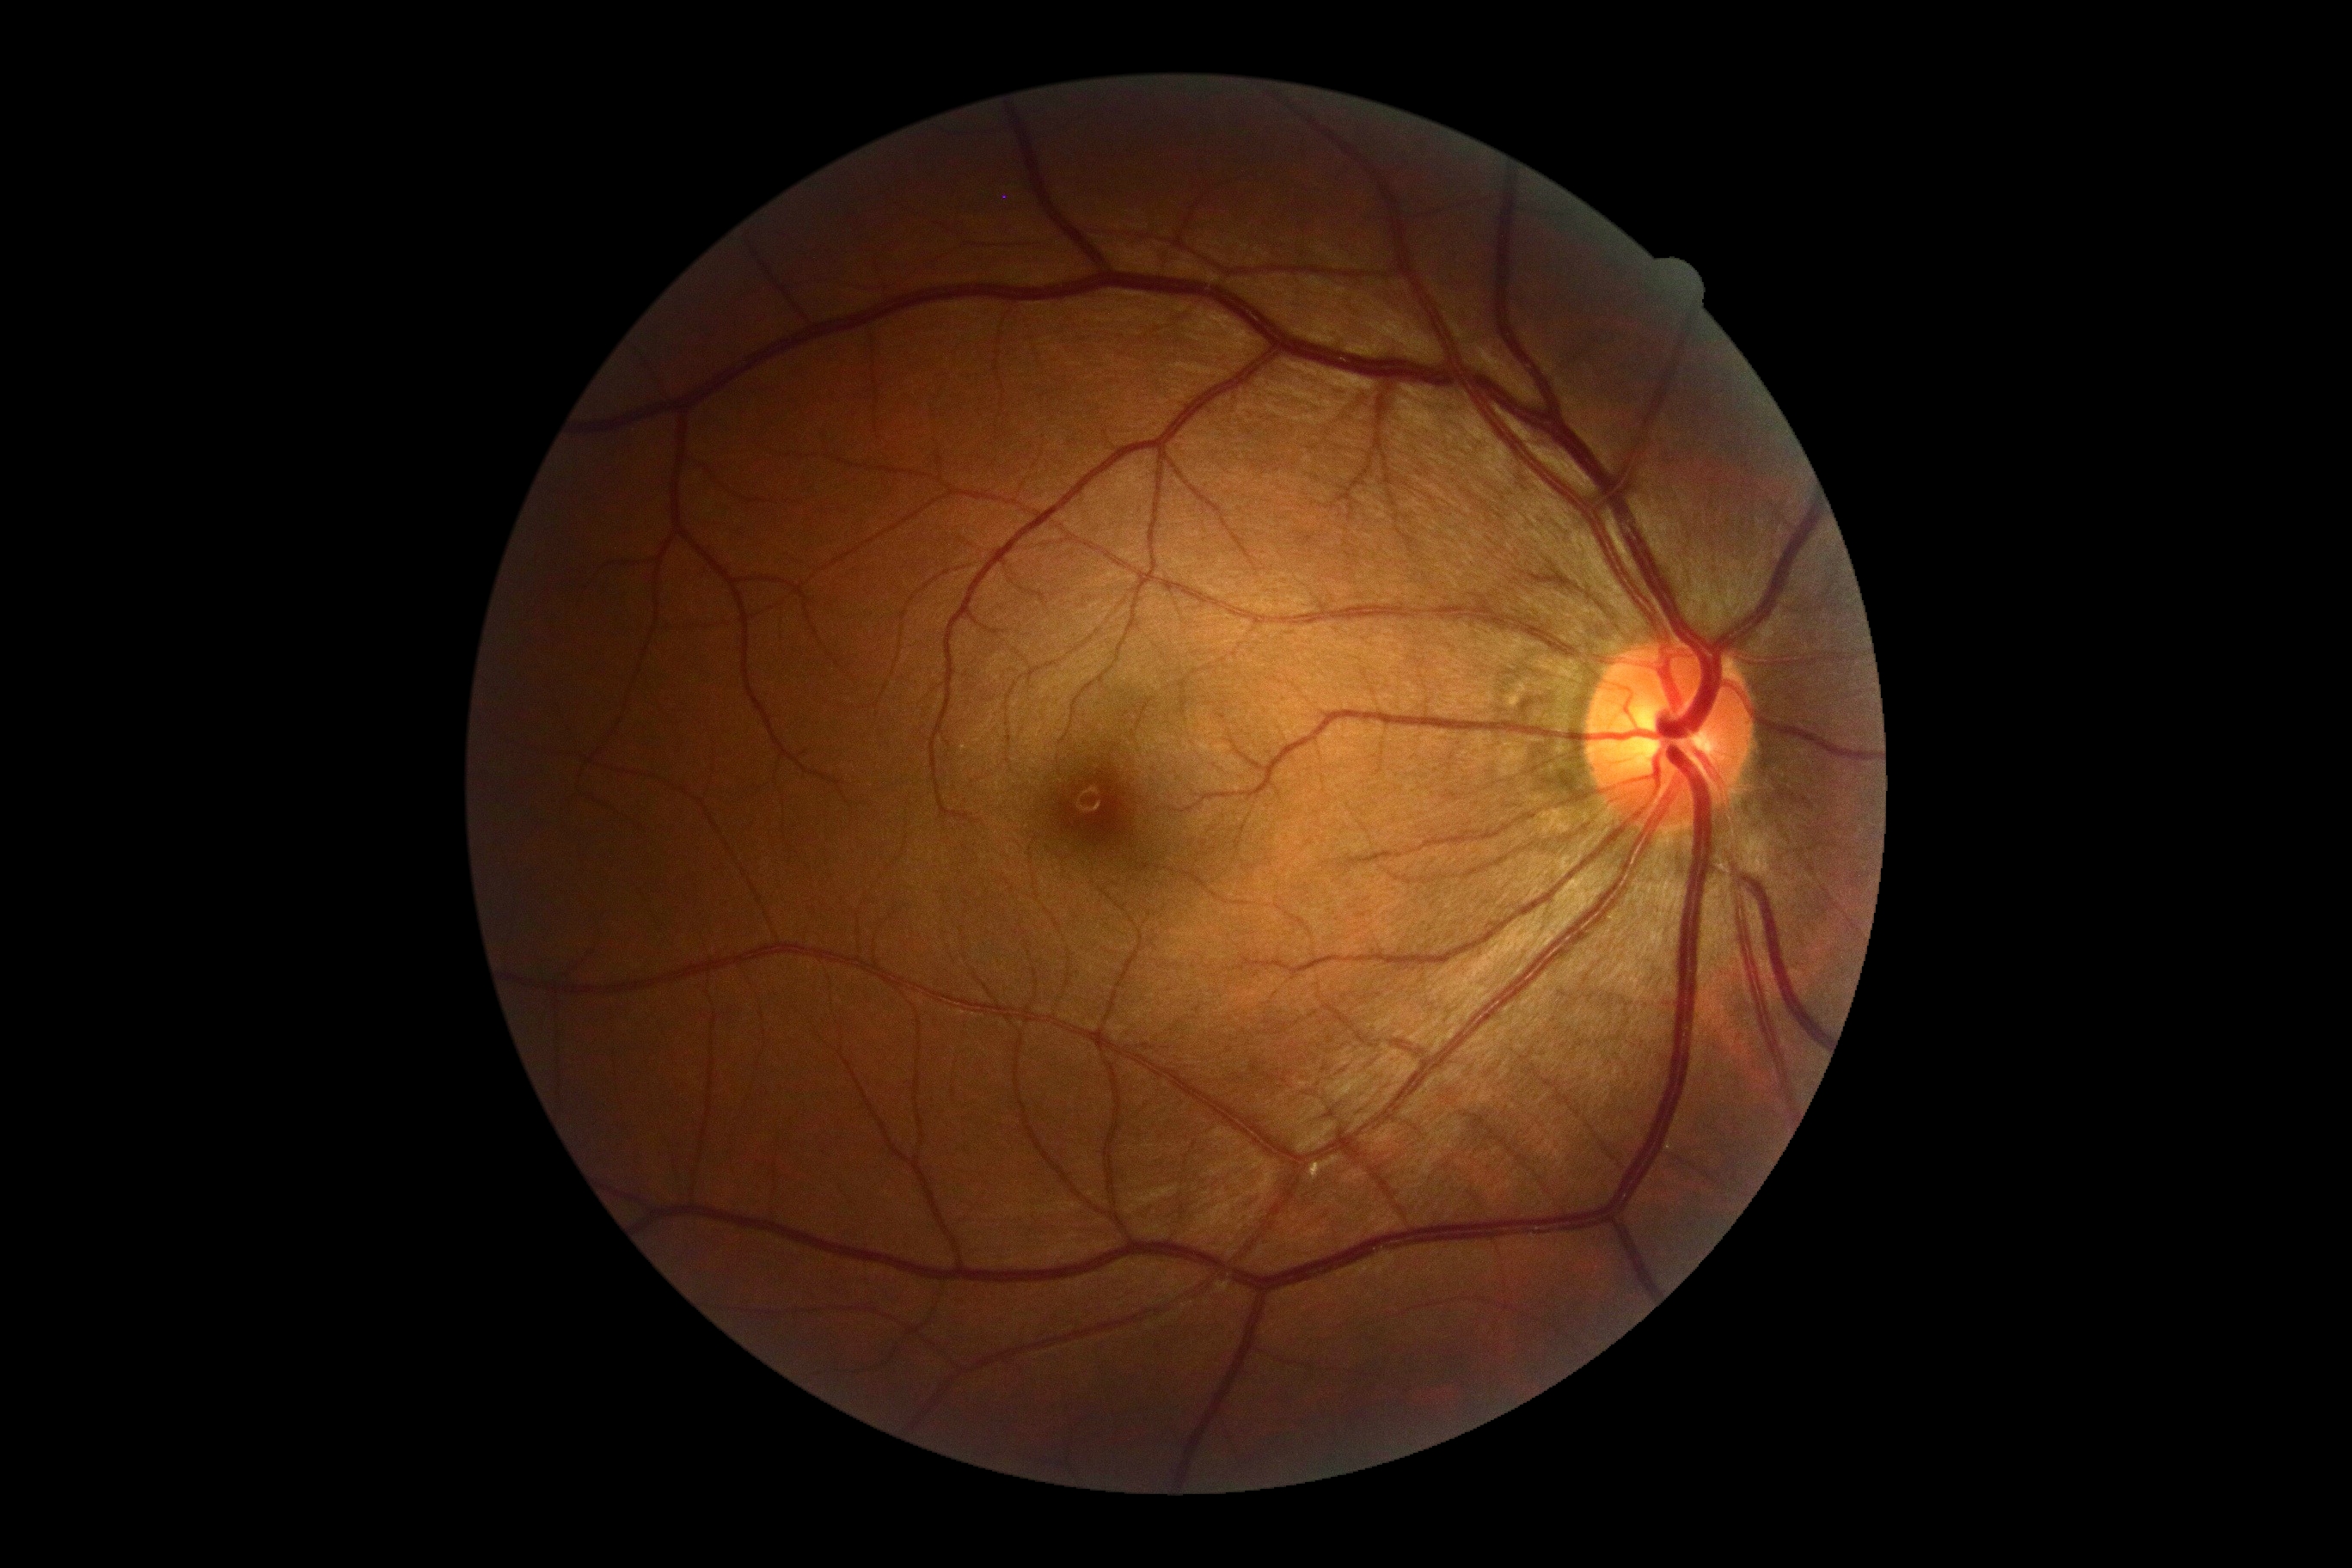
Retinopathy: grade 0 (no apparent retinopathy). No apparent diabetic retinopathy.